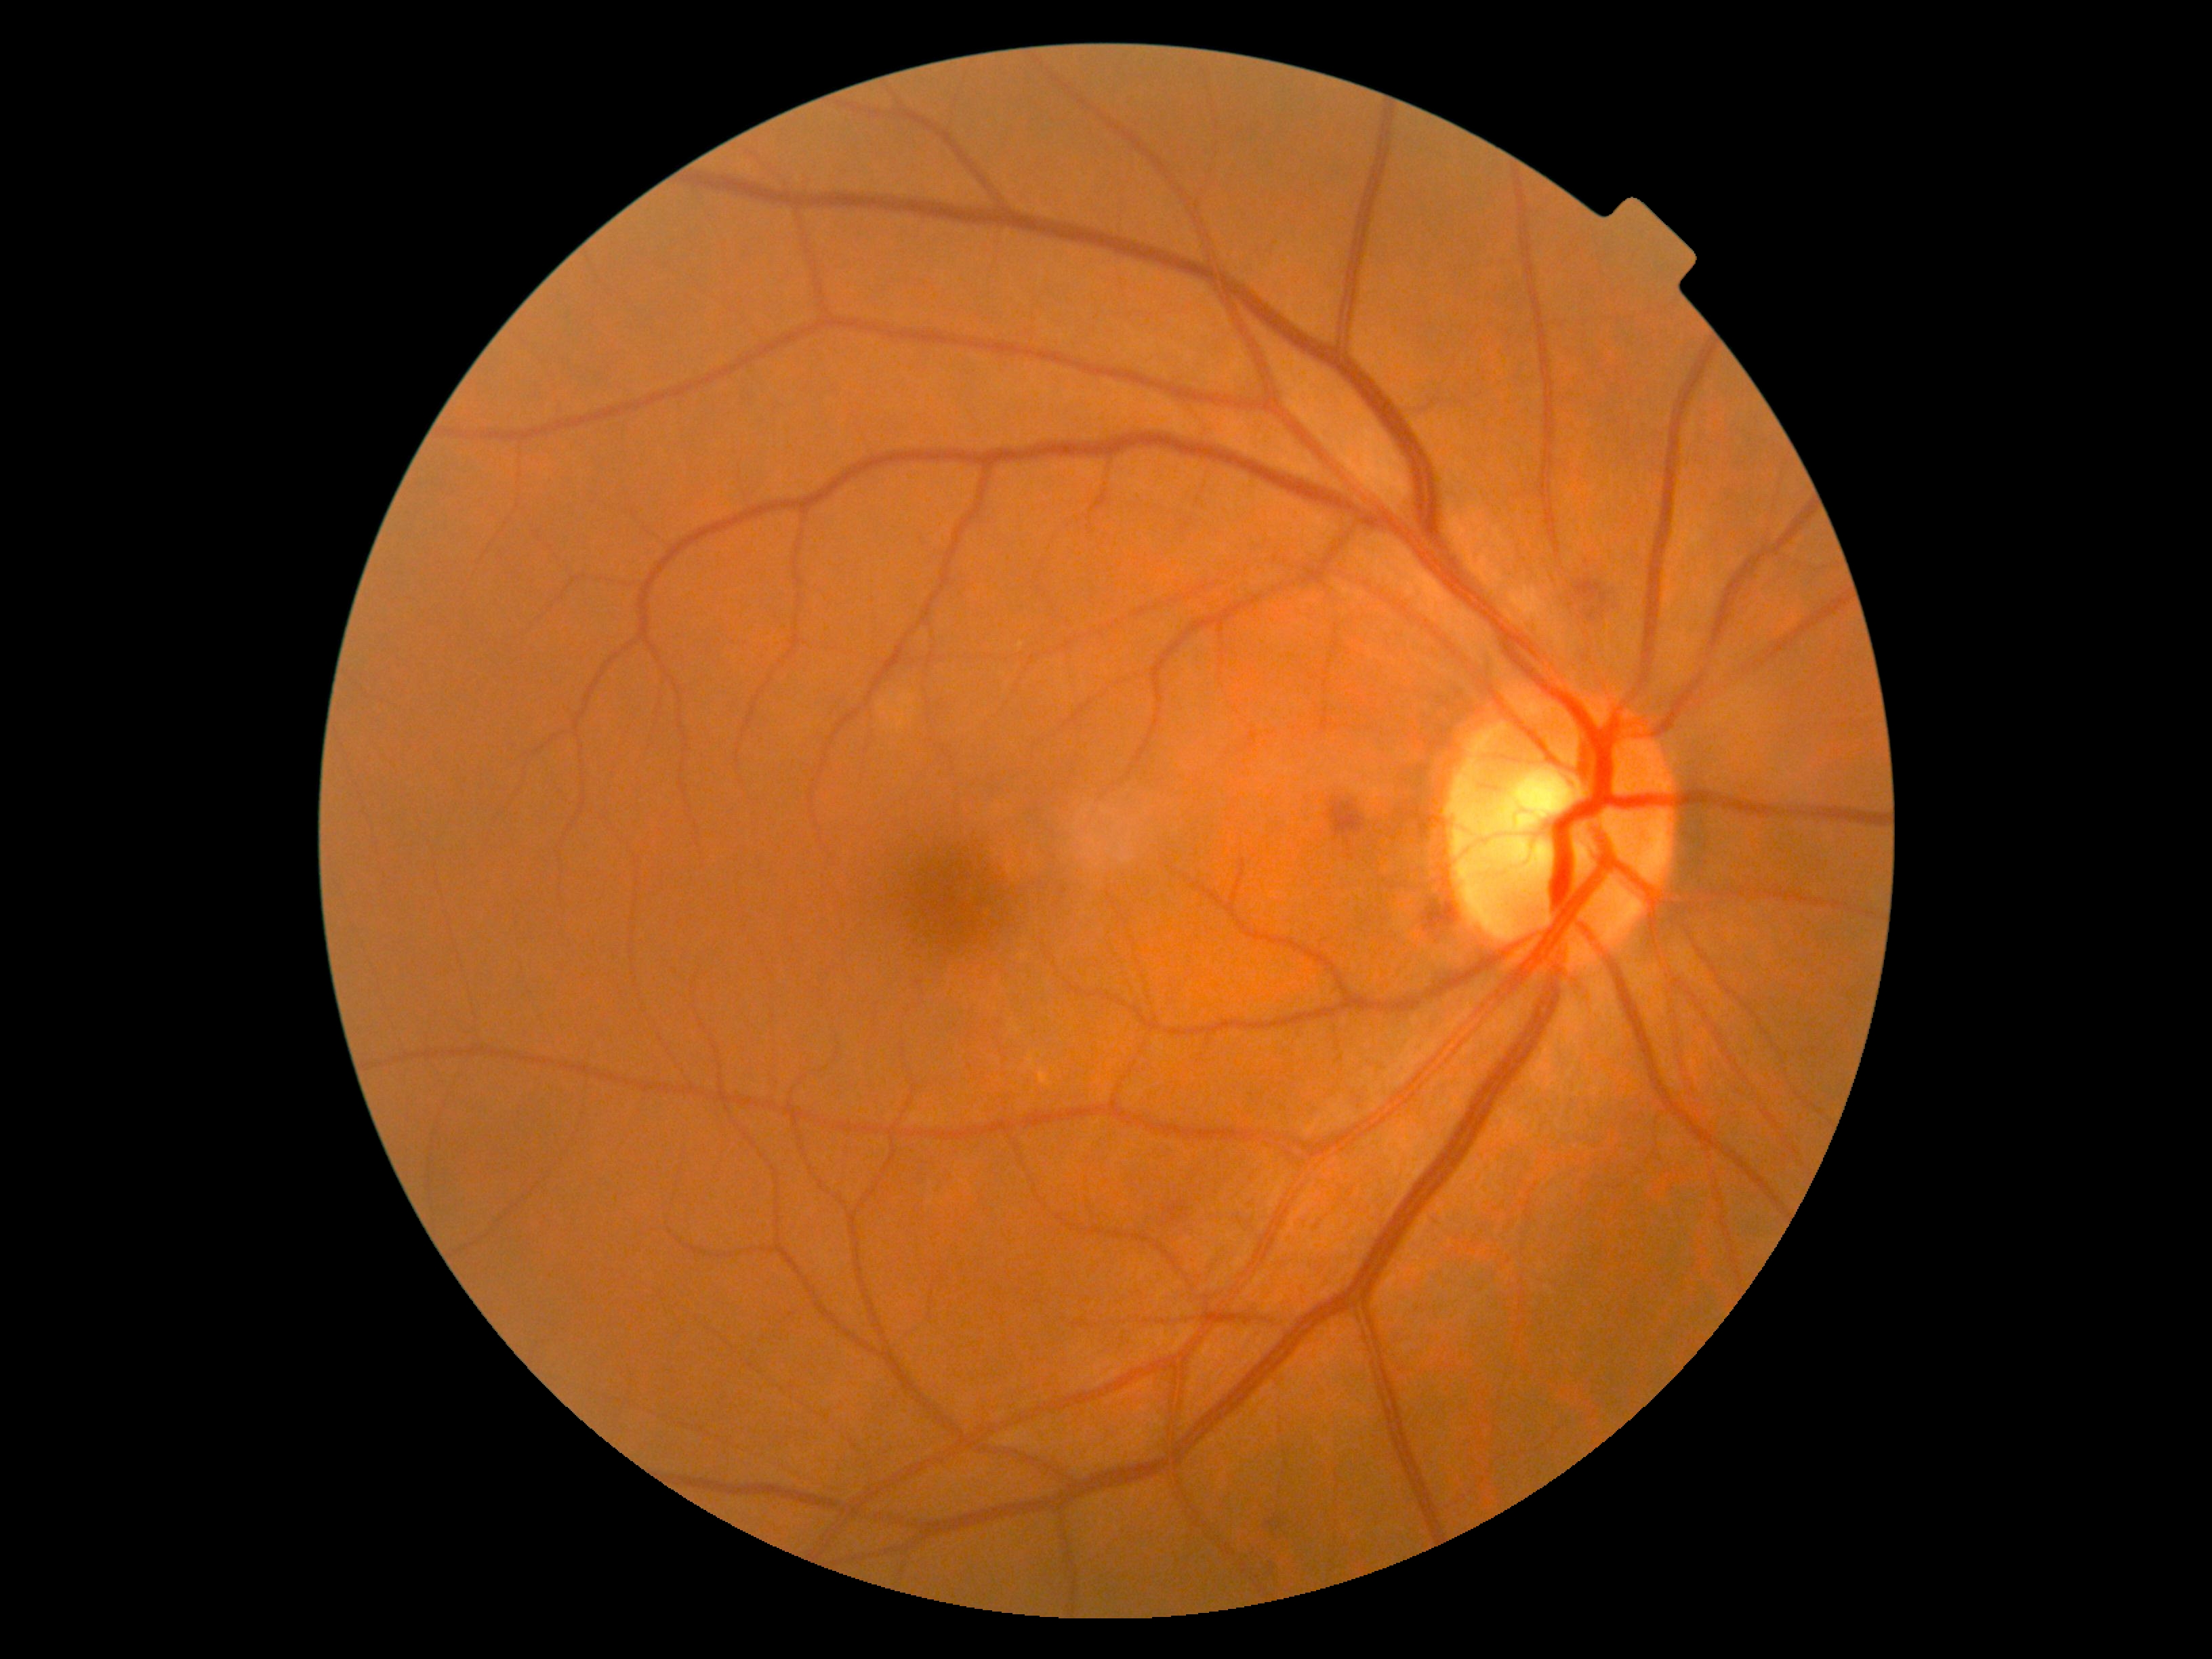
retinopathy=moderate non-proliferative diabetic retinopathy (grade 2).